Wide-field fundus image from infant ROP screening:
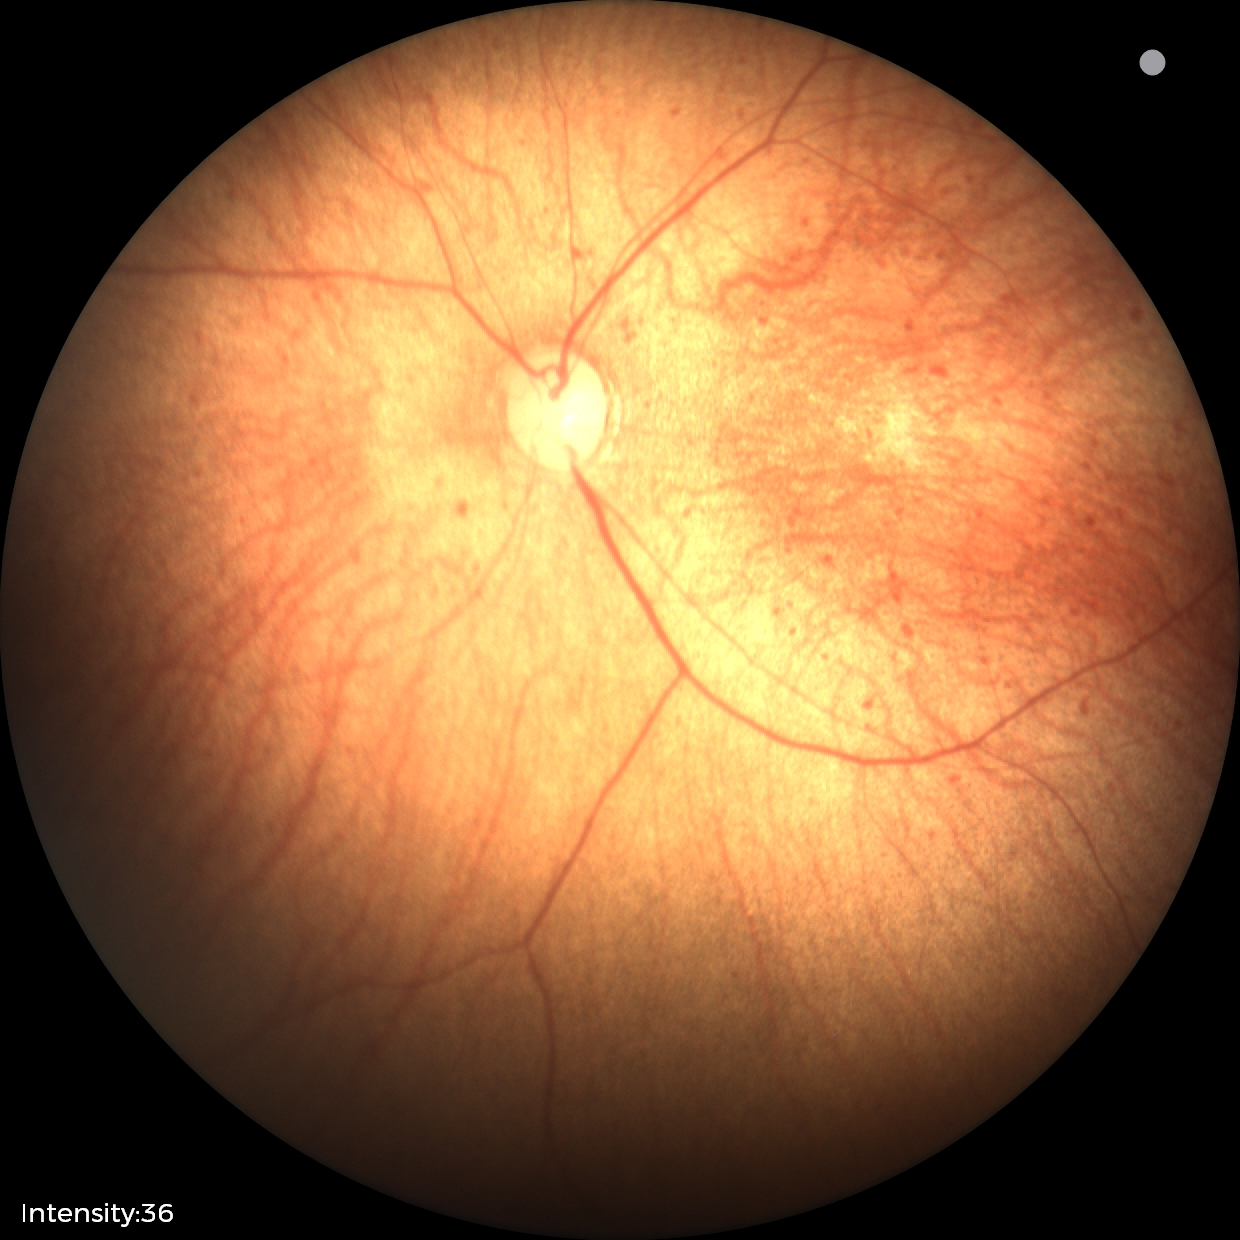
No retinal pathology identified on screening.